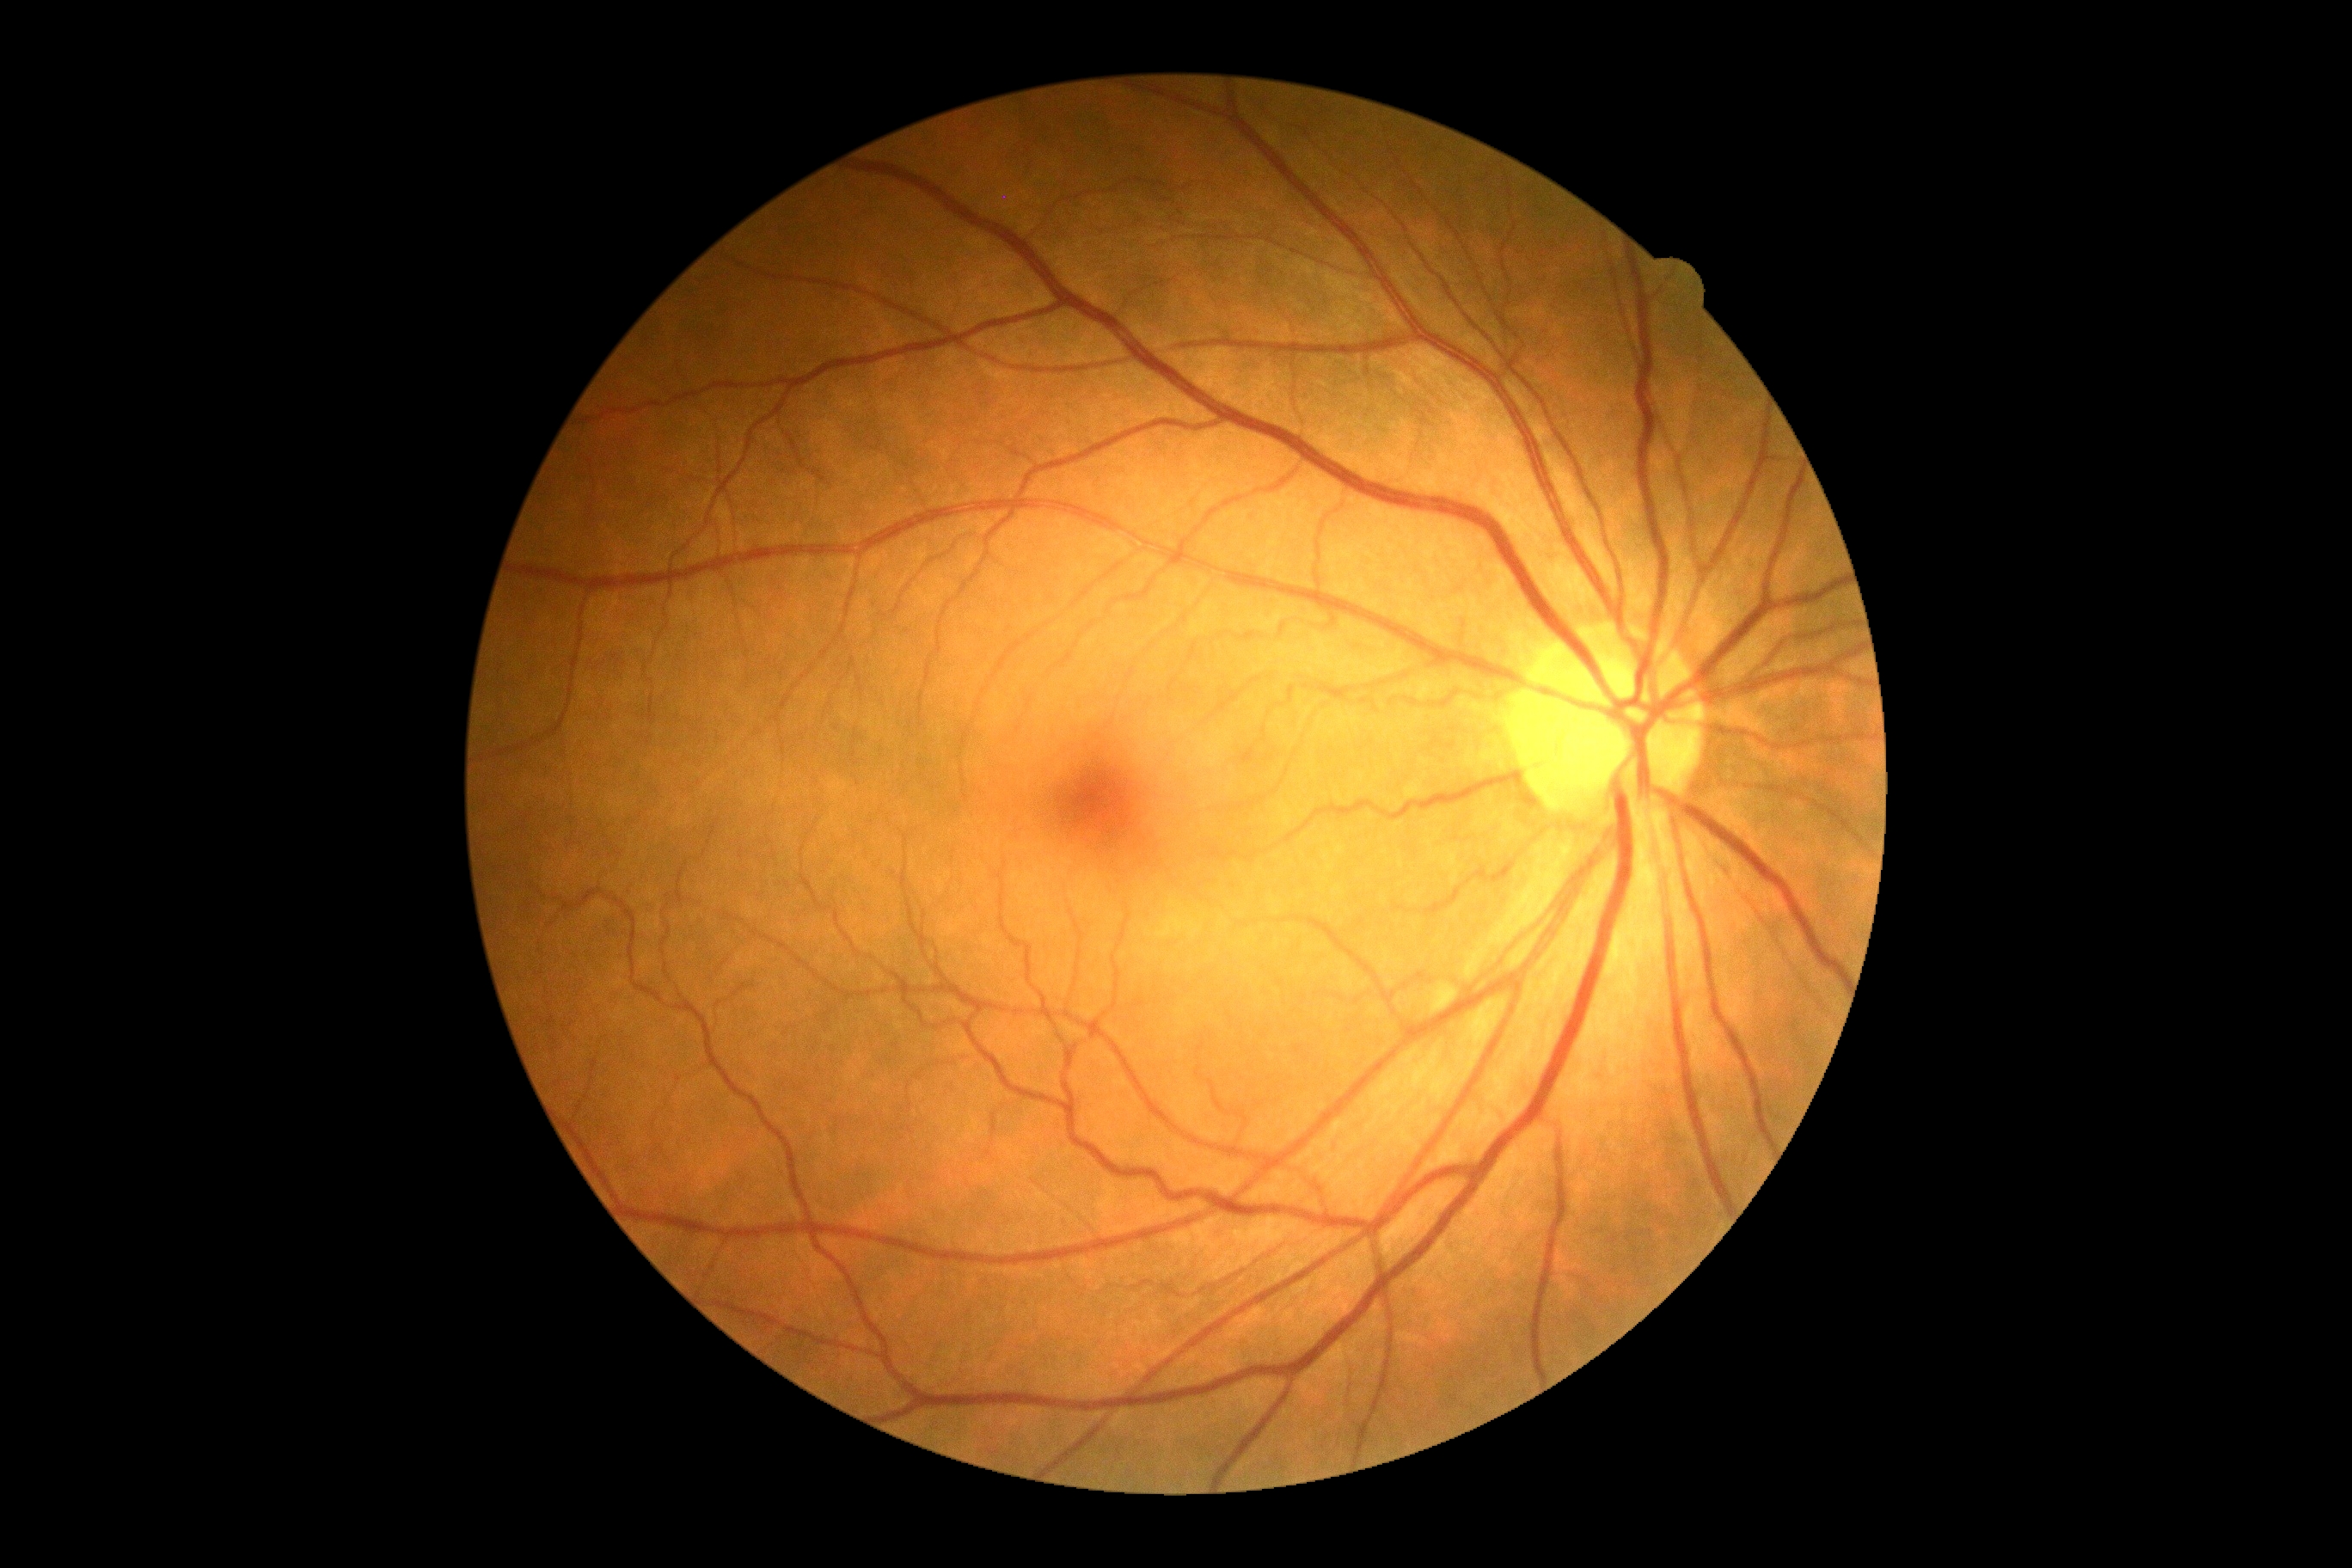 No signs of diabetic retinopathy. Diabetic retinopathy (DR): grade 0 (no apparent retinopathy).